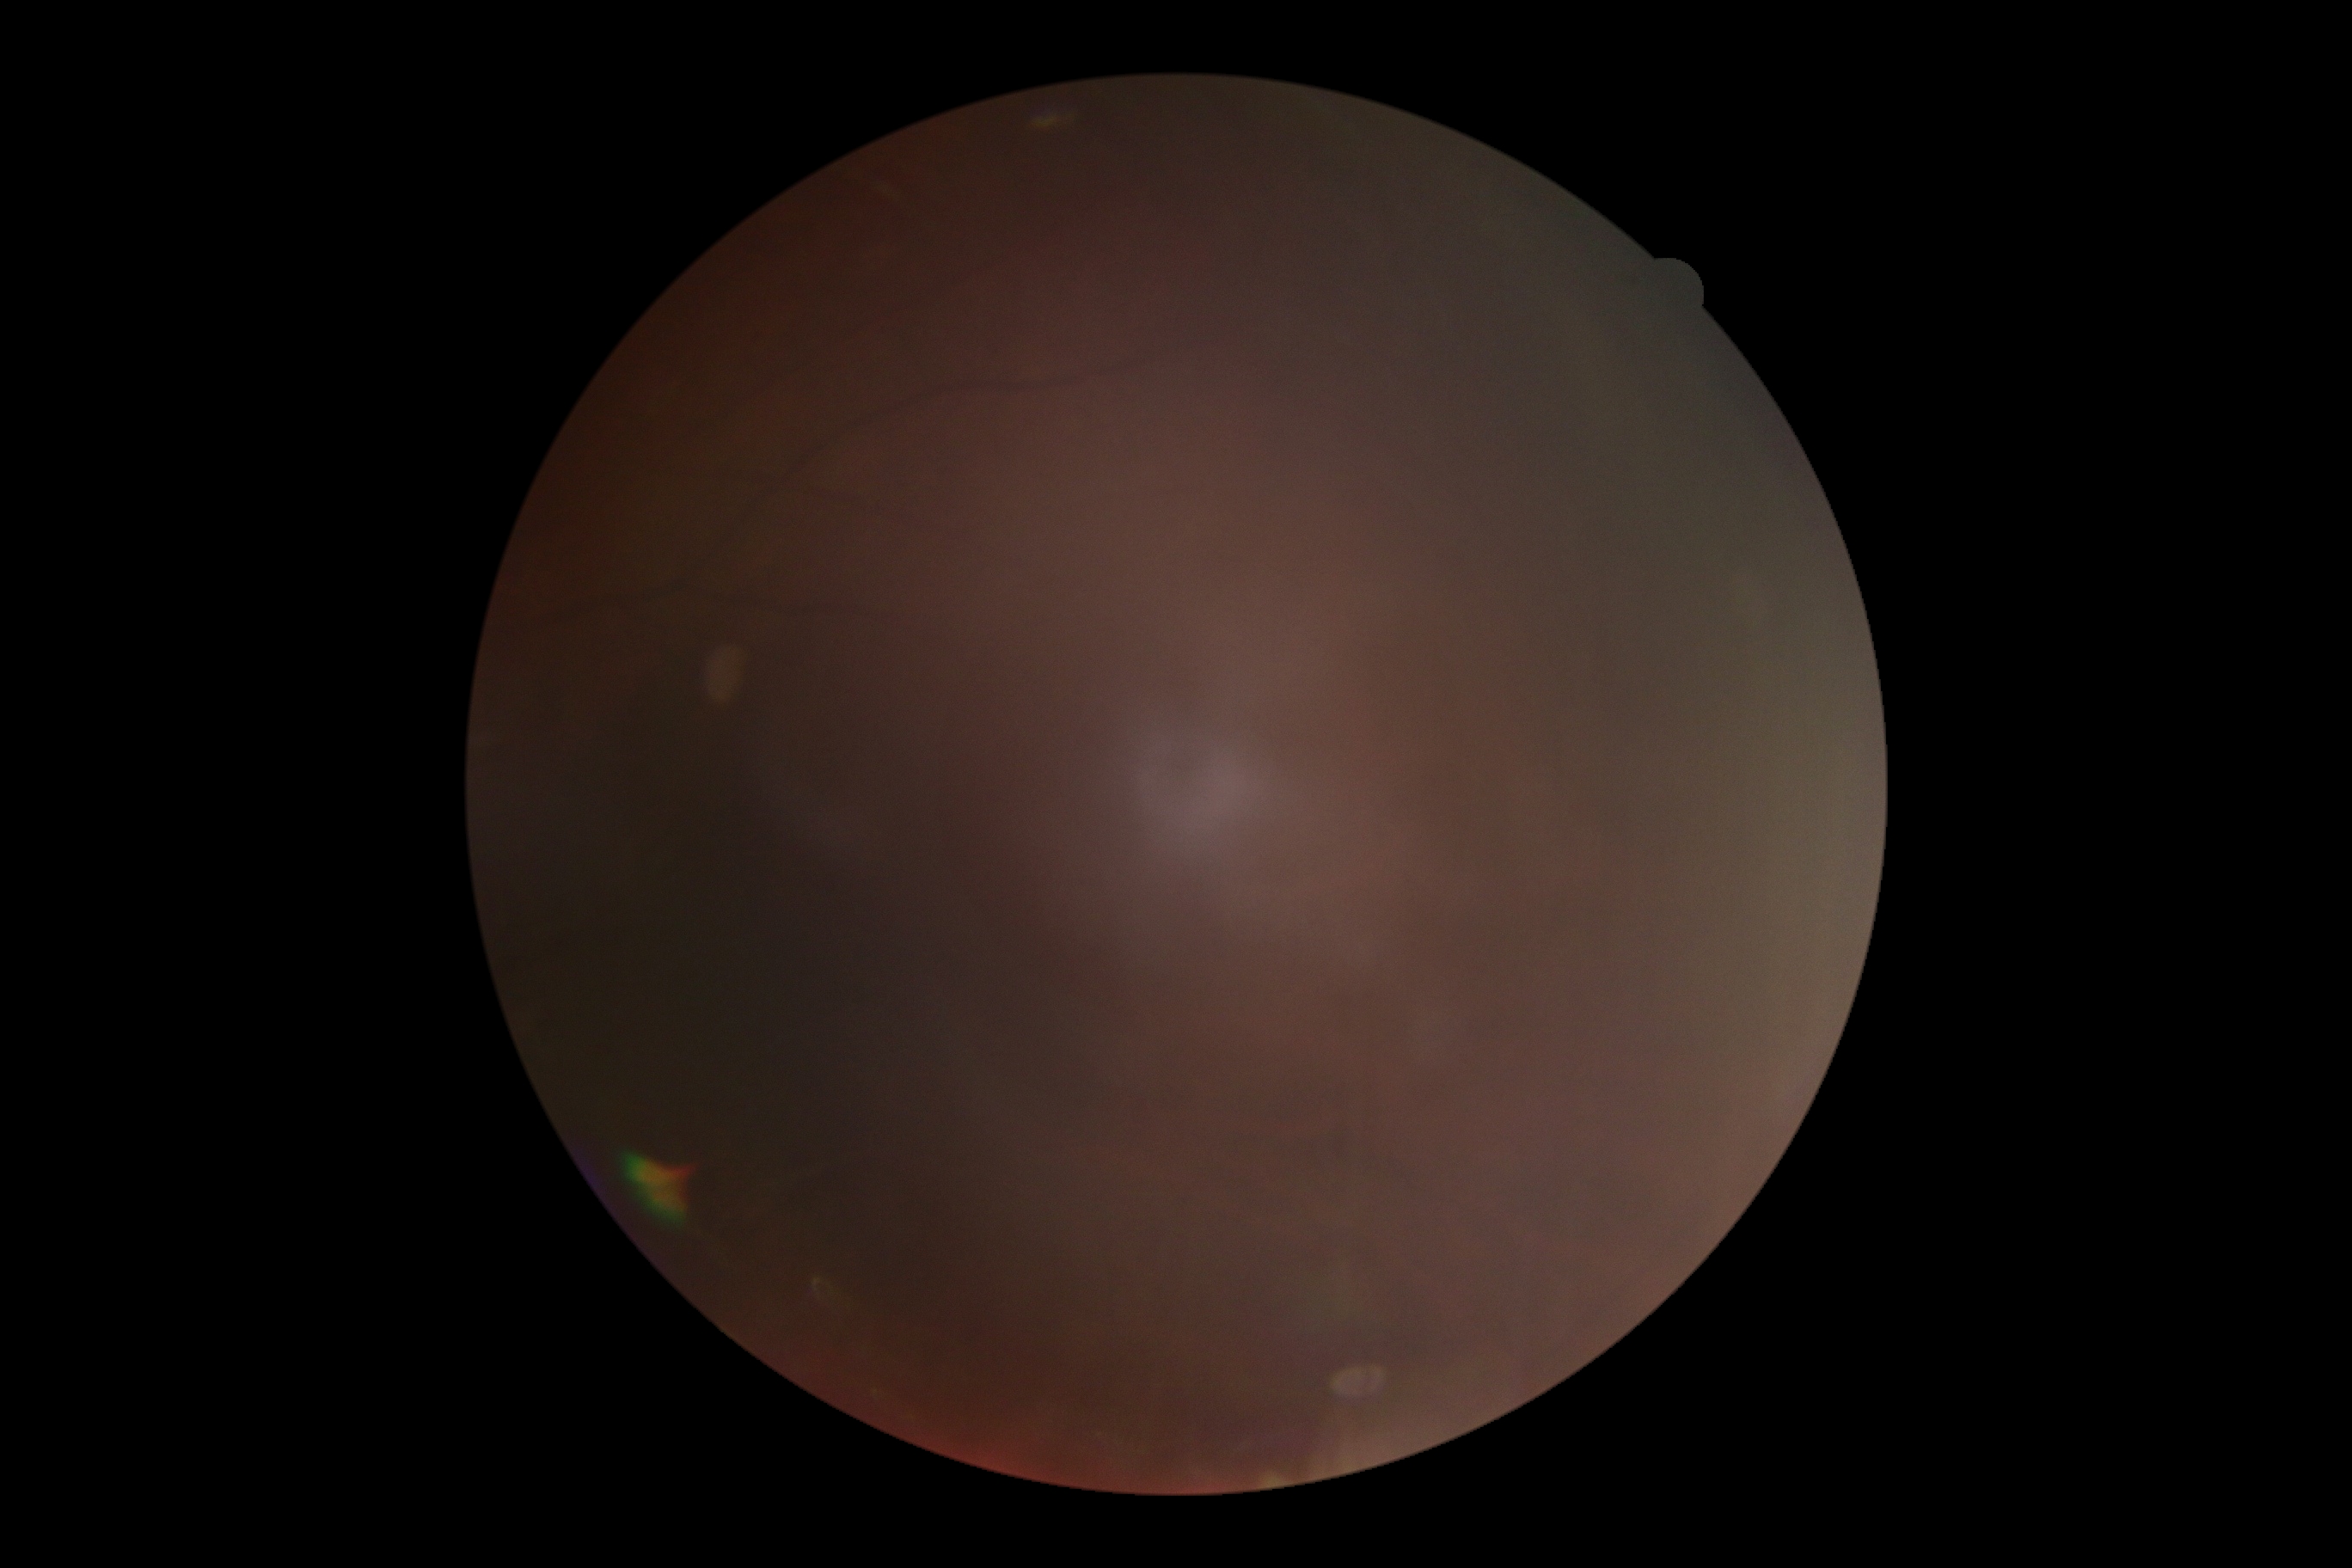

Diabetic retinopathy: ungradable. The image cannot be graded for diabetic retinopathy.